Image size 1659x2212; color fundus photograph; Remidio FOP fundus camera:
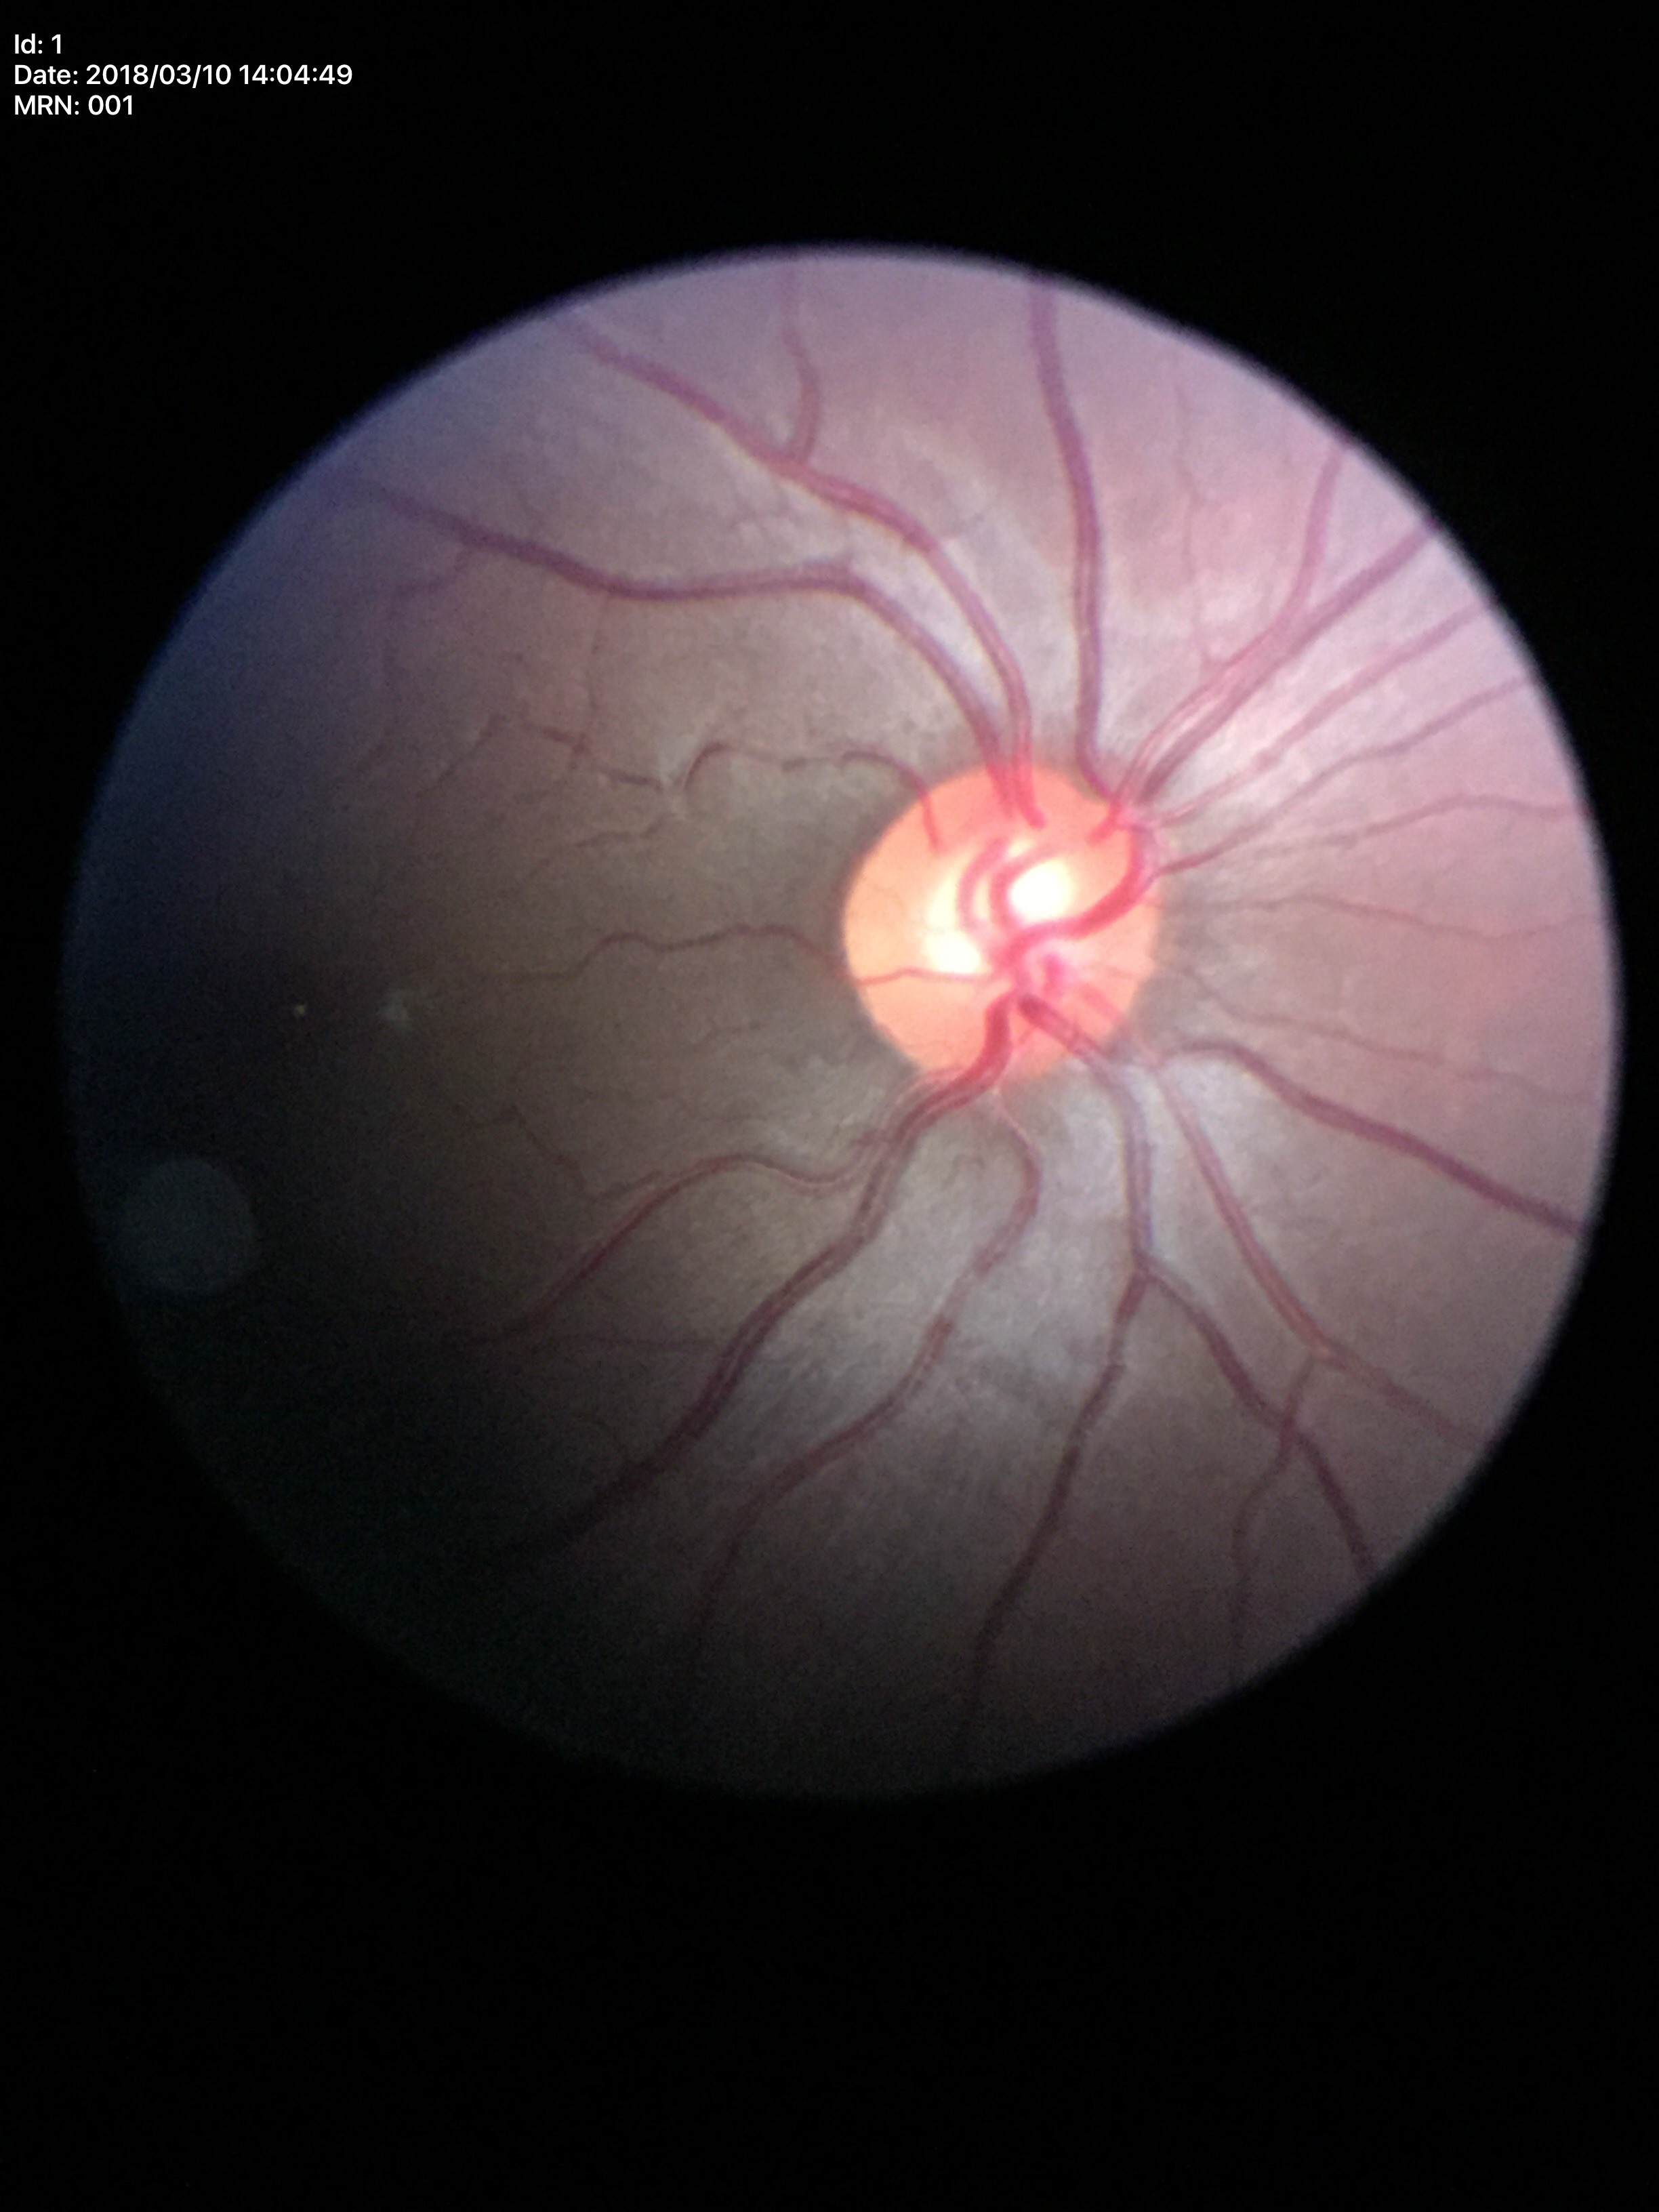

Q: What is the VCDR?
A: 0.55
Q: What is the ACDR?
A: 0.30
Q: Glaucoma screening result?
A: not suspect (1/5 graders called glaucoma suspect)